640x480; RetCam wide-field infant fundus image.
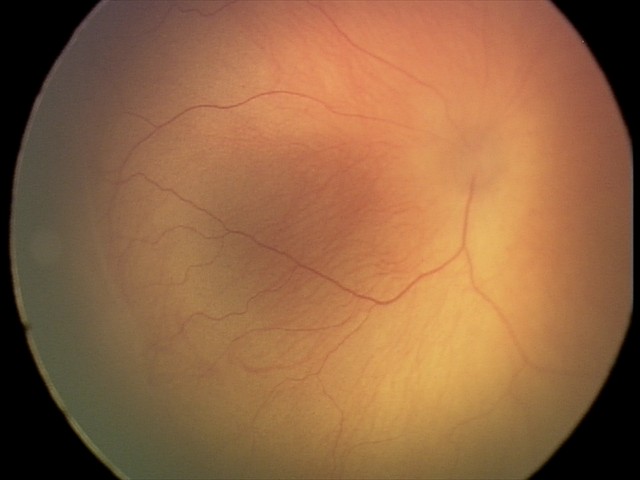

Without plus disease. Screening examination consistent with retinopathy of prematurity (ROP) stage 1.